Captured with the Clarity RetCam 3 (130° field of view). 640x480px. Pediatric retinal photograph (wide-field).
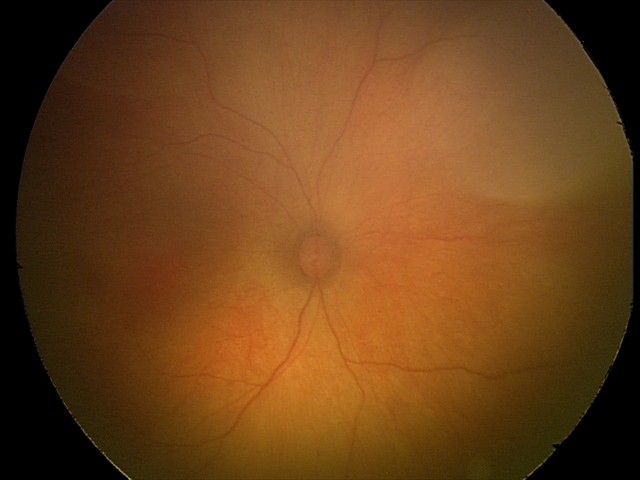 Screening diagnosis = physiological appearance.